Fundus photo · 45-degree field of view · without pupil dilation — 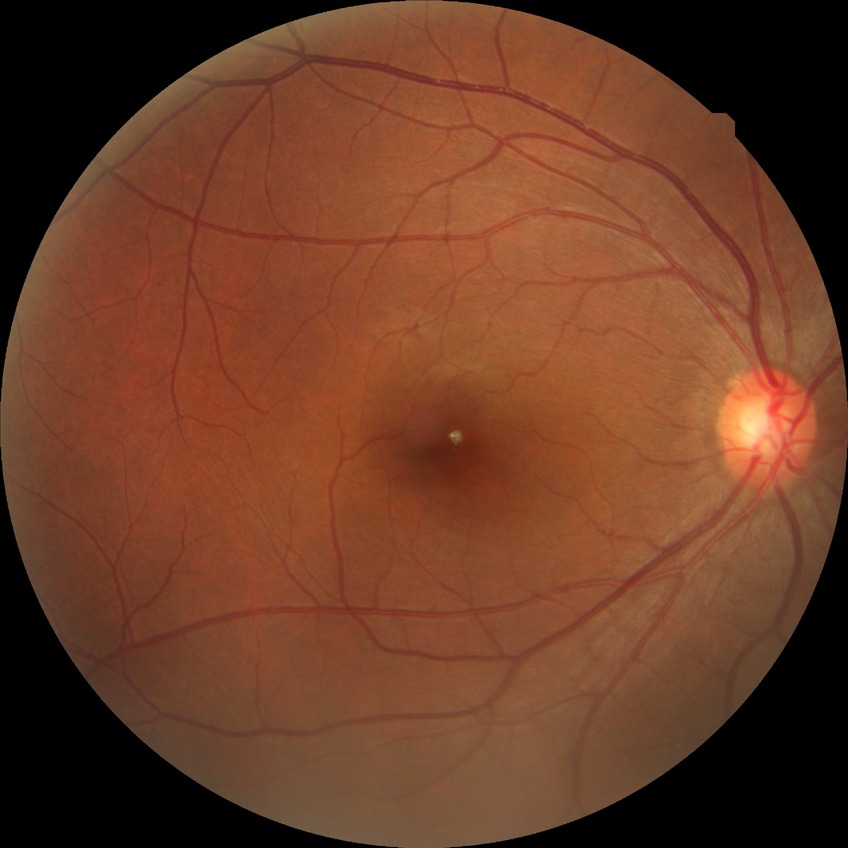

diabetic retinopathy (DR) = no diabetic retinopathy (NDR).